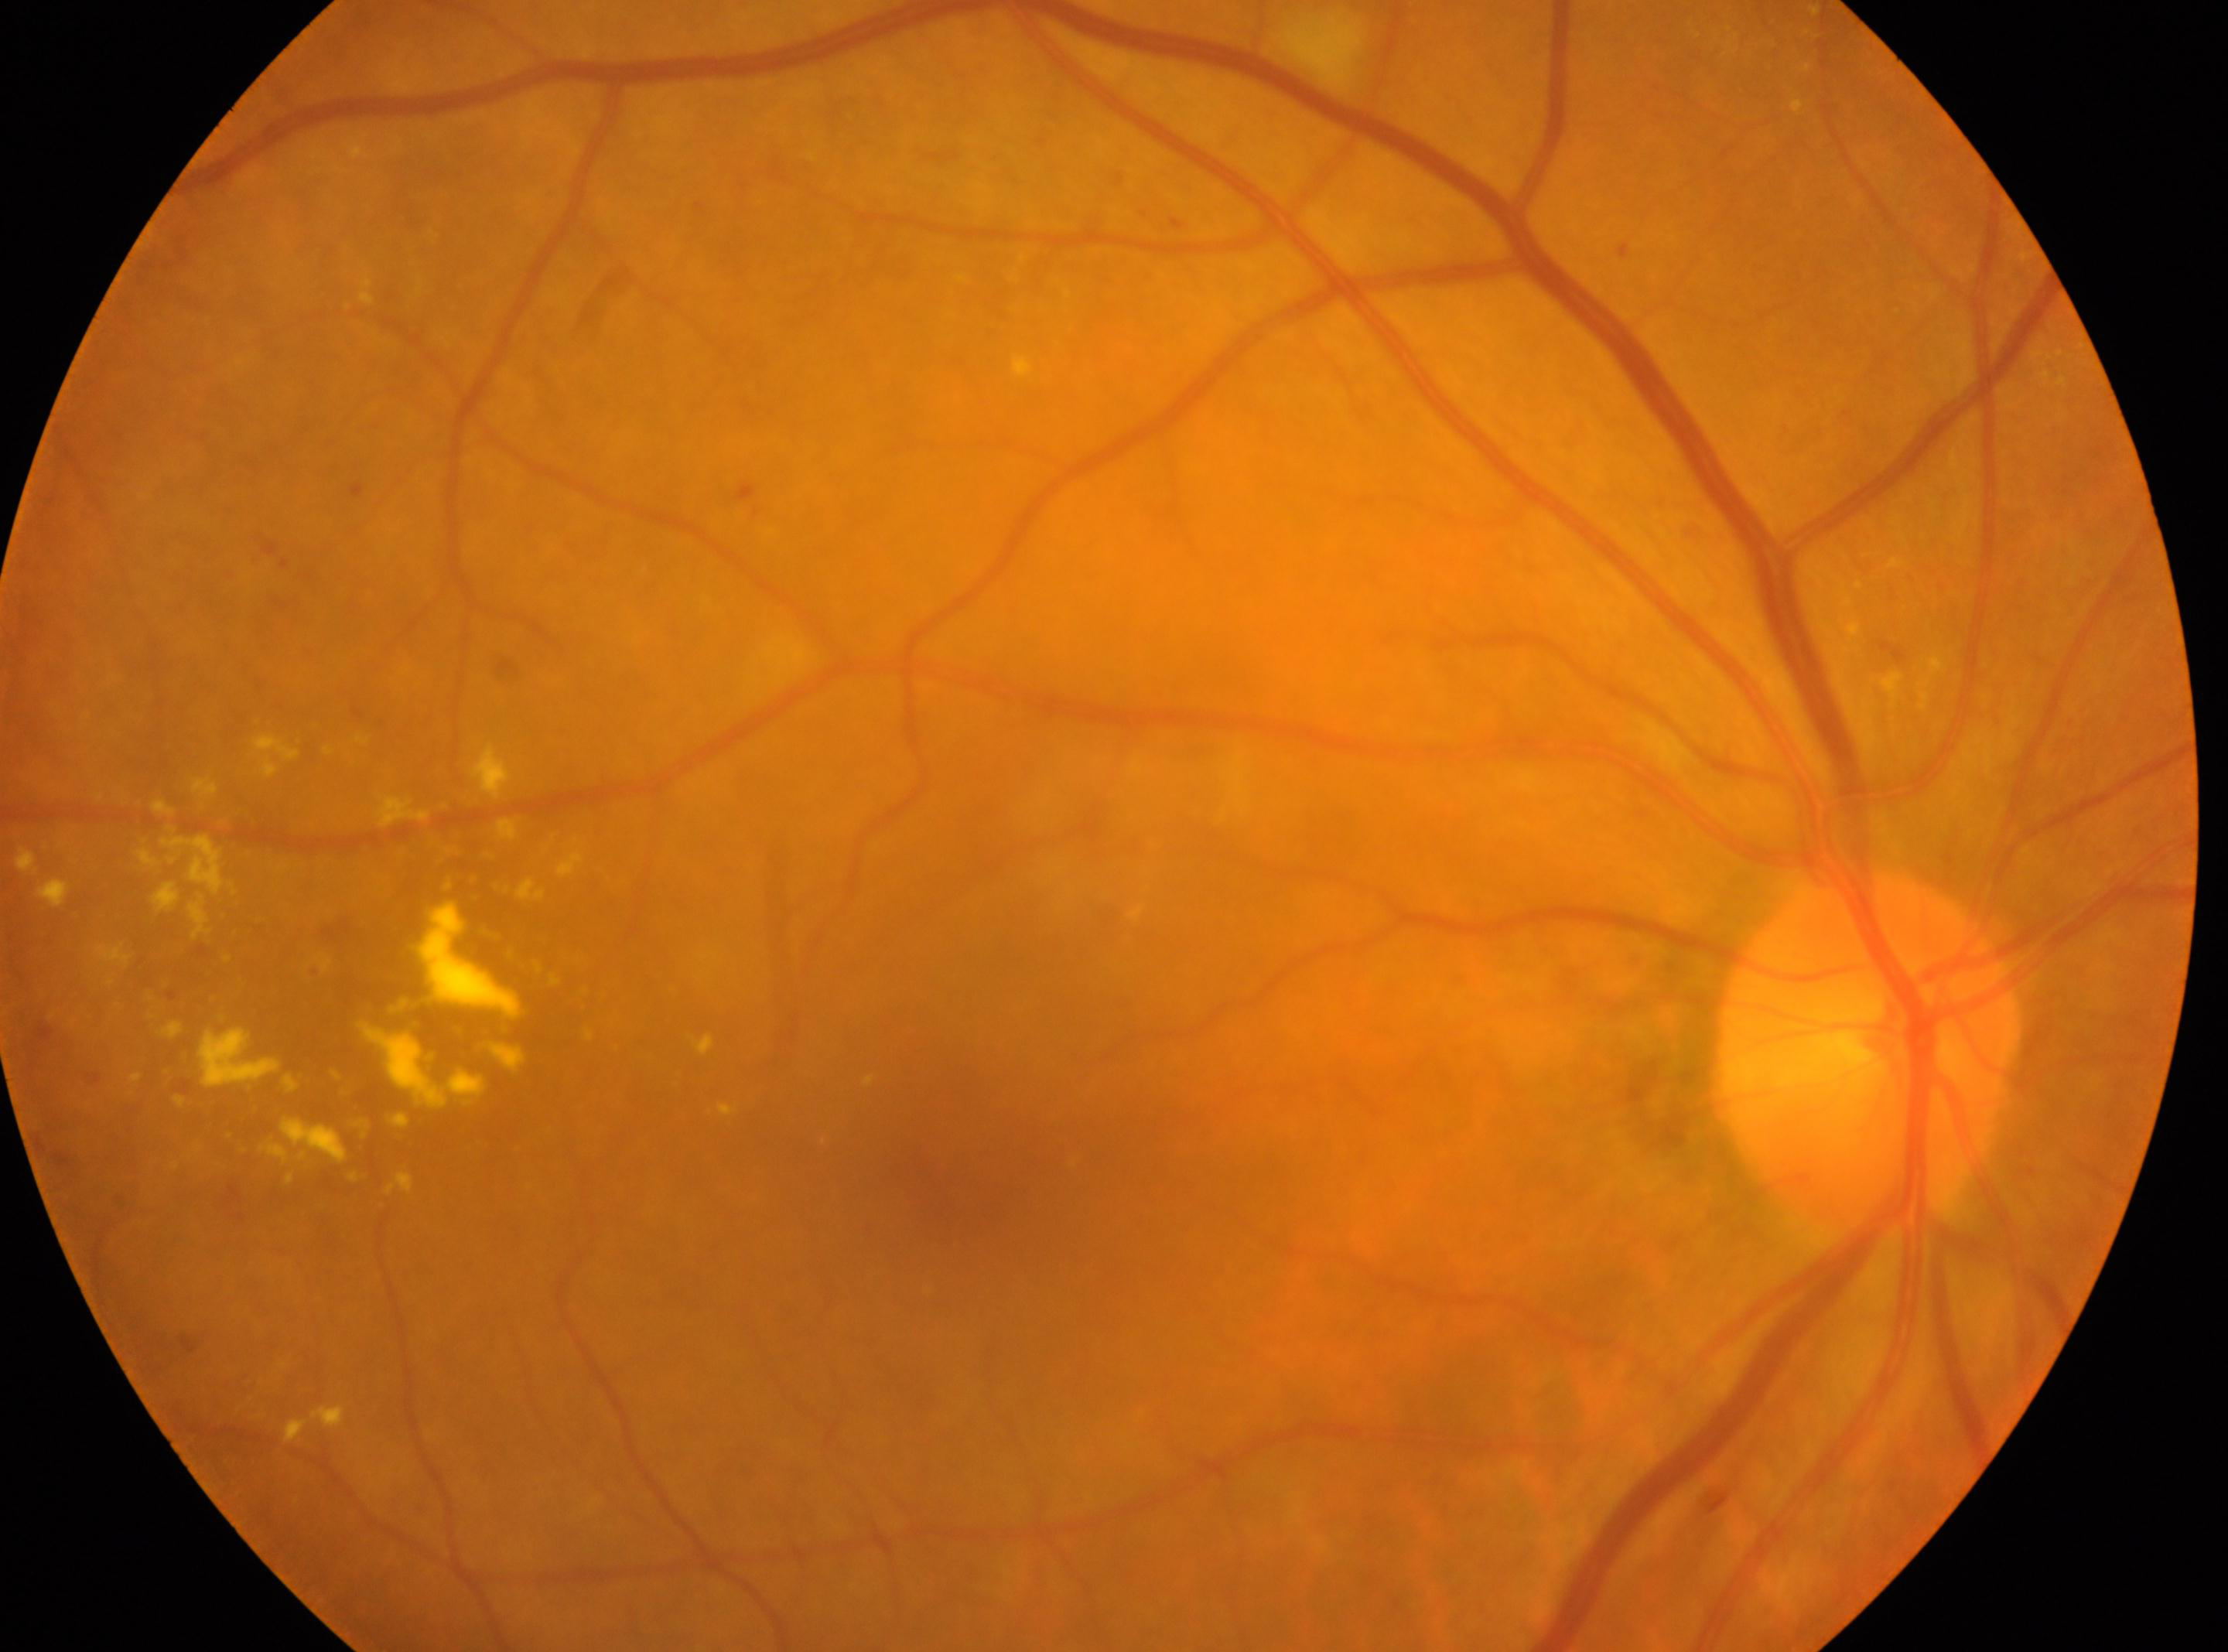 This is the right eye. Optic disc center: (x=1864, y=1051). DR: moderate NPDR (grade 2) — more than just microaneurysms but less than severe NPDR. The foveal center is at (x=955, y=1168).